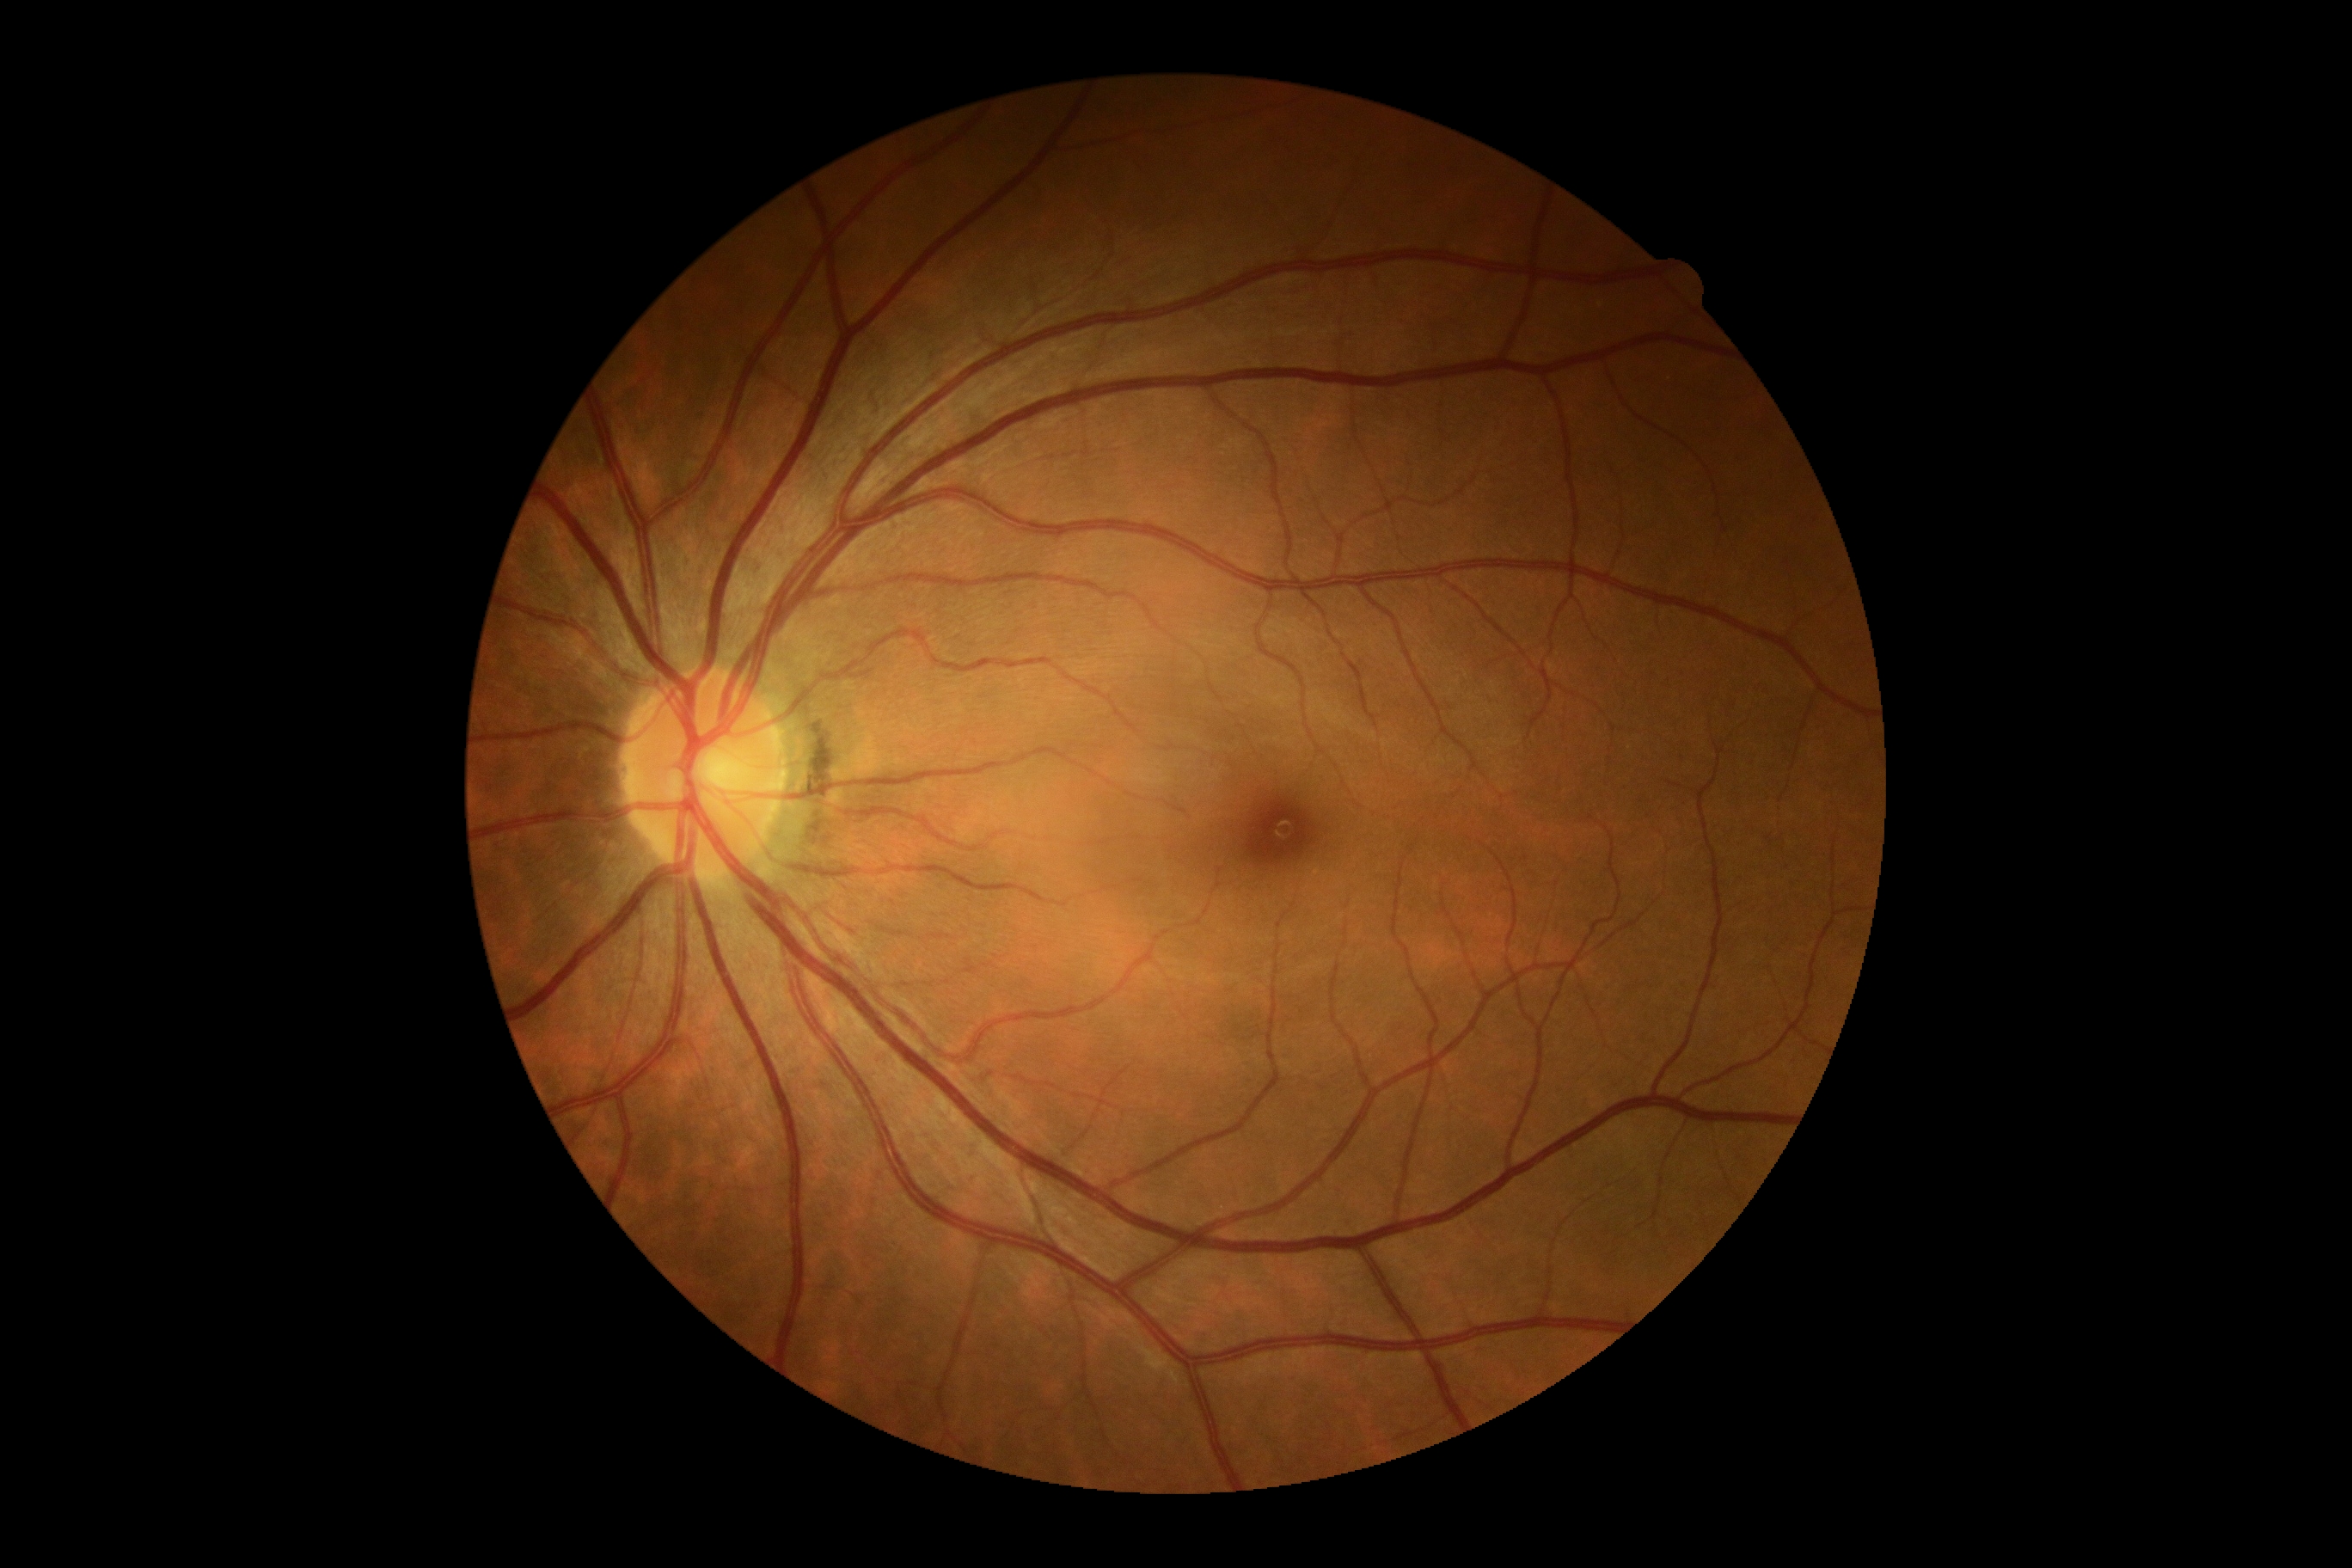 No DR findings. DR stage is grade 0 (no apparent retinopathy).